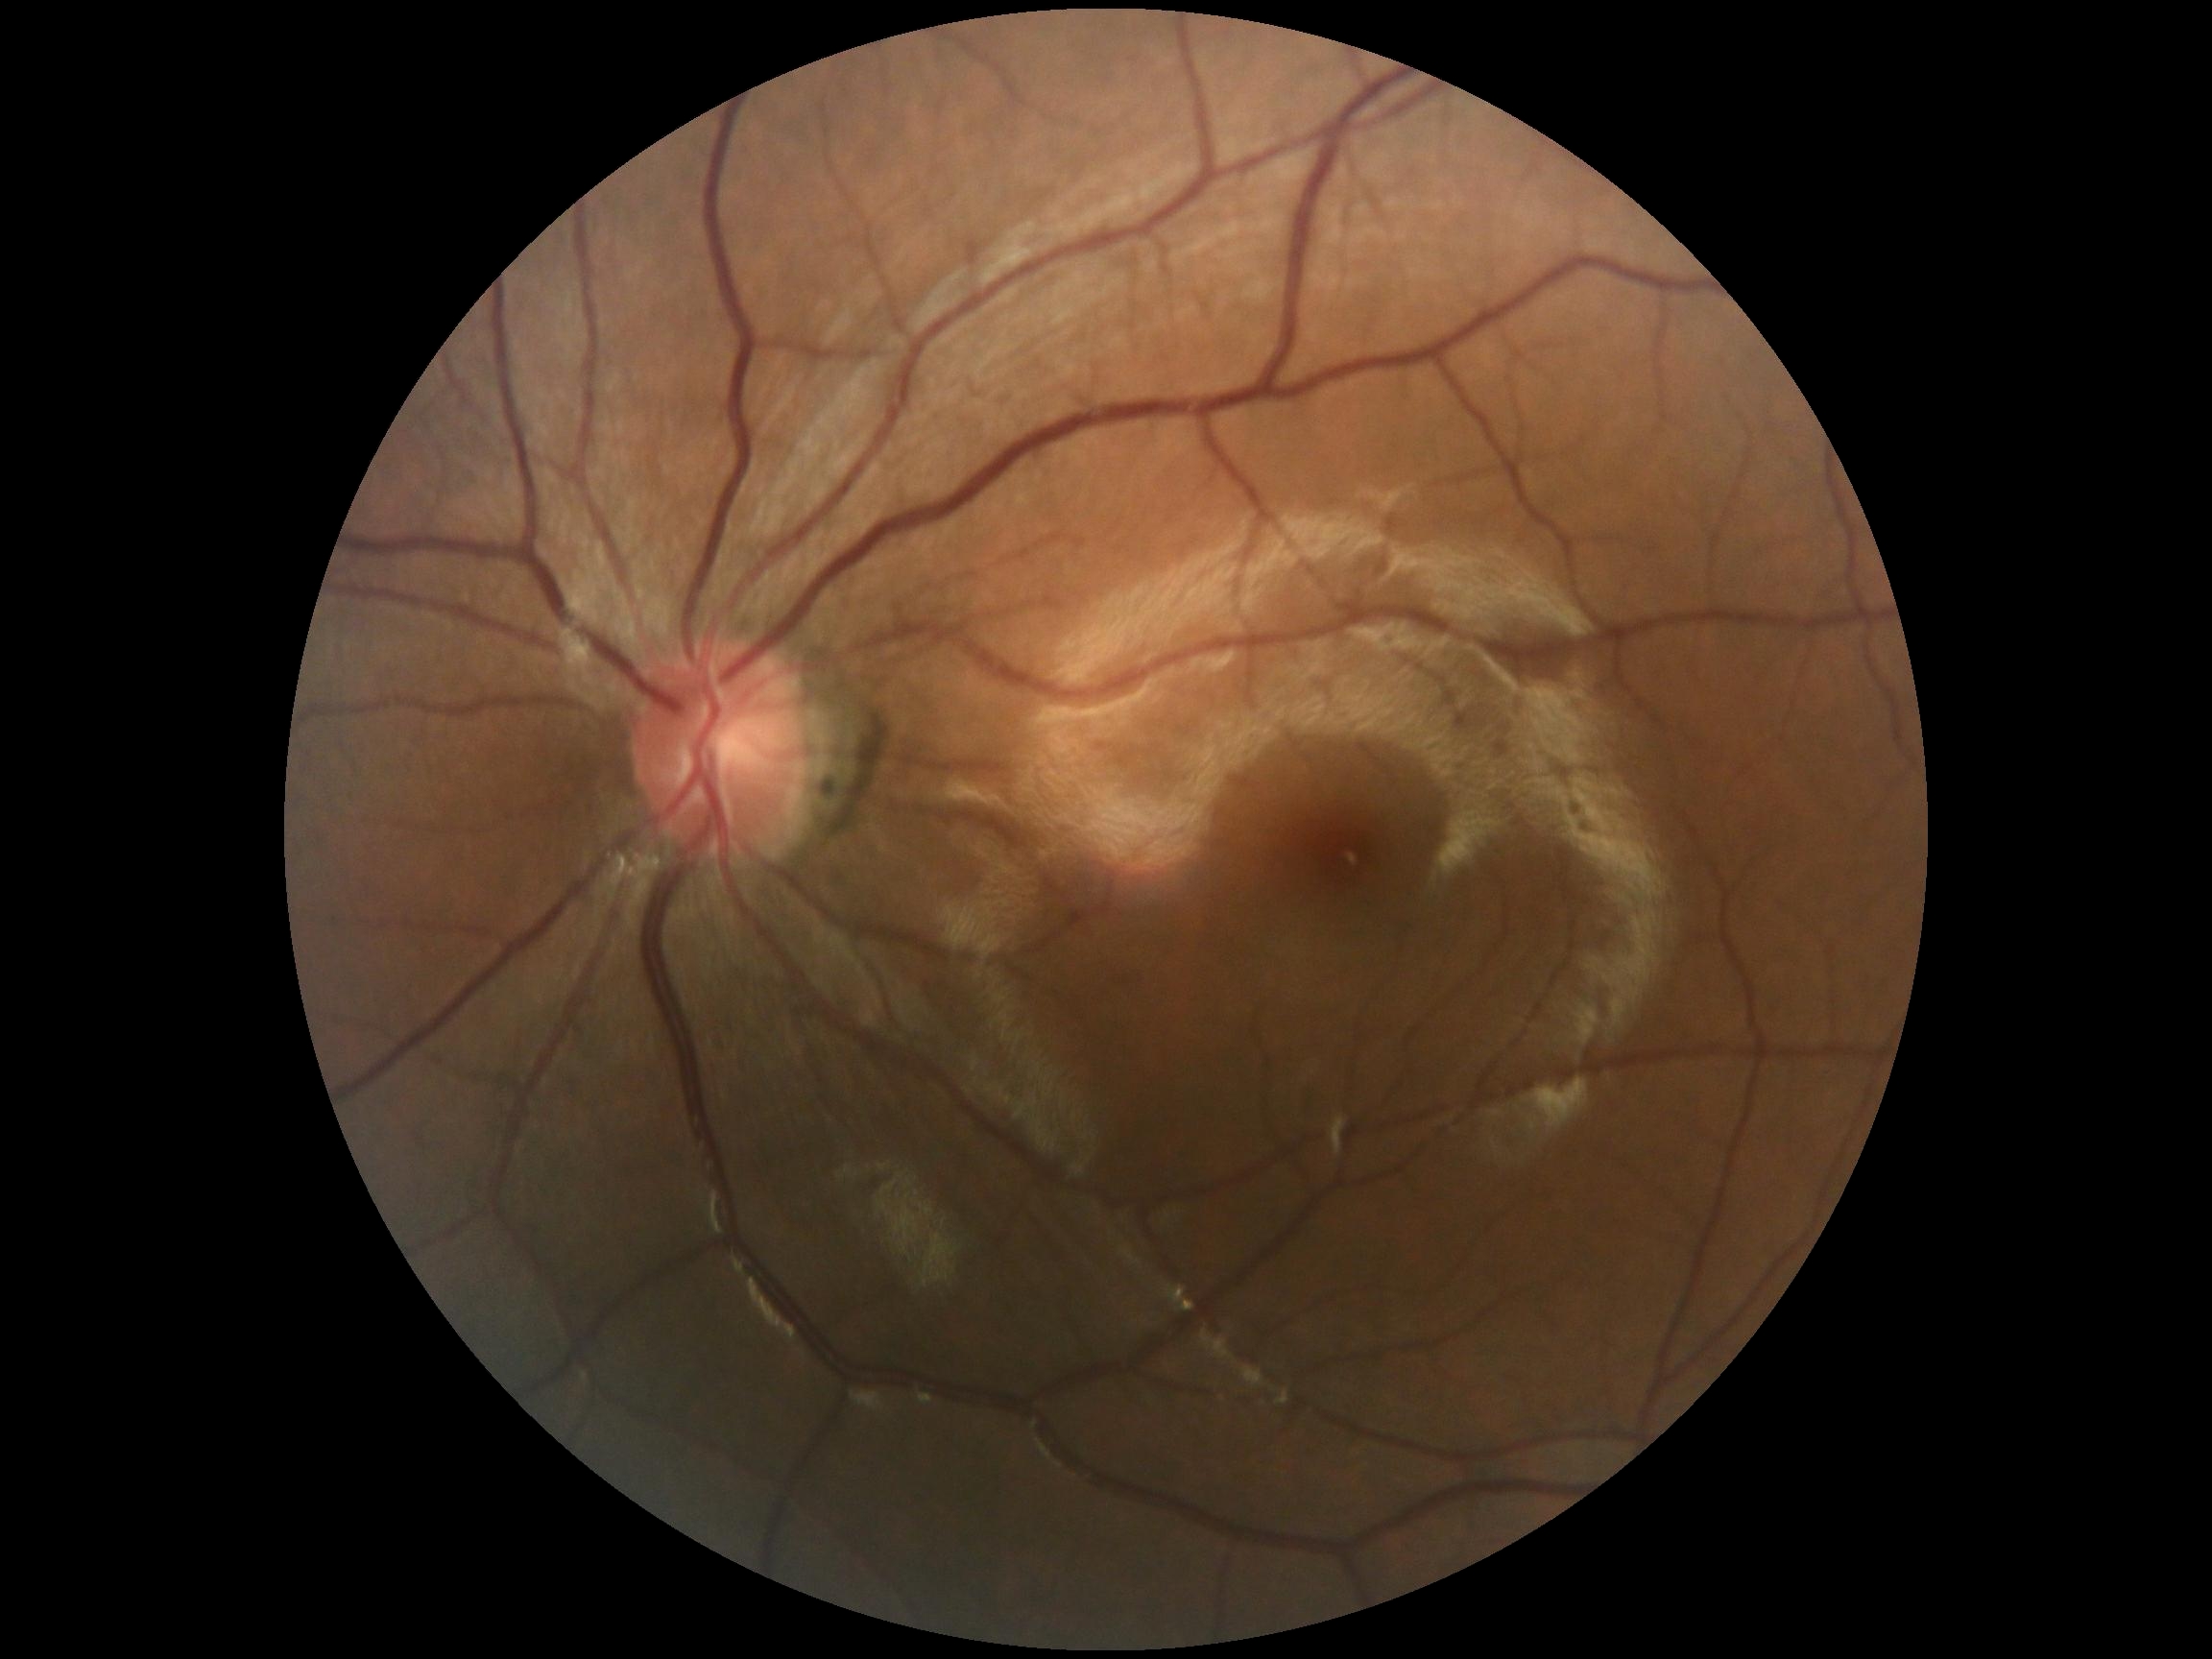

diabetic retinopathy grade: no apparent retinopathy (0)